Image size 1932x1910 — 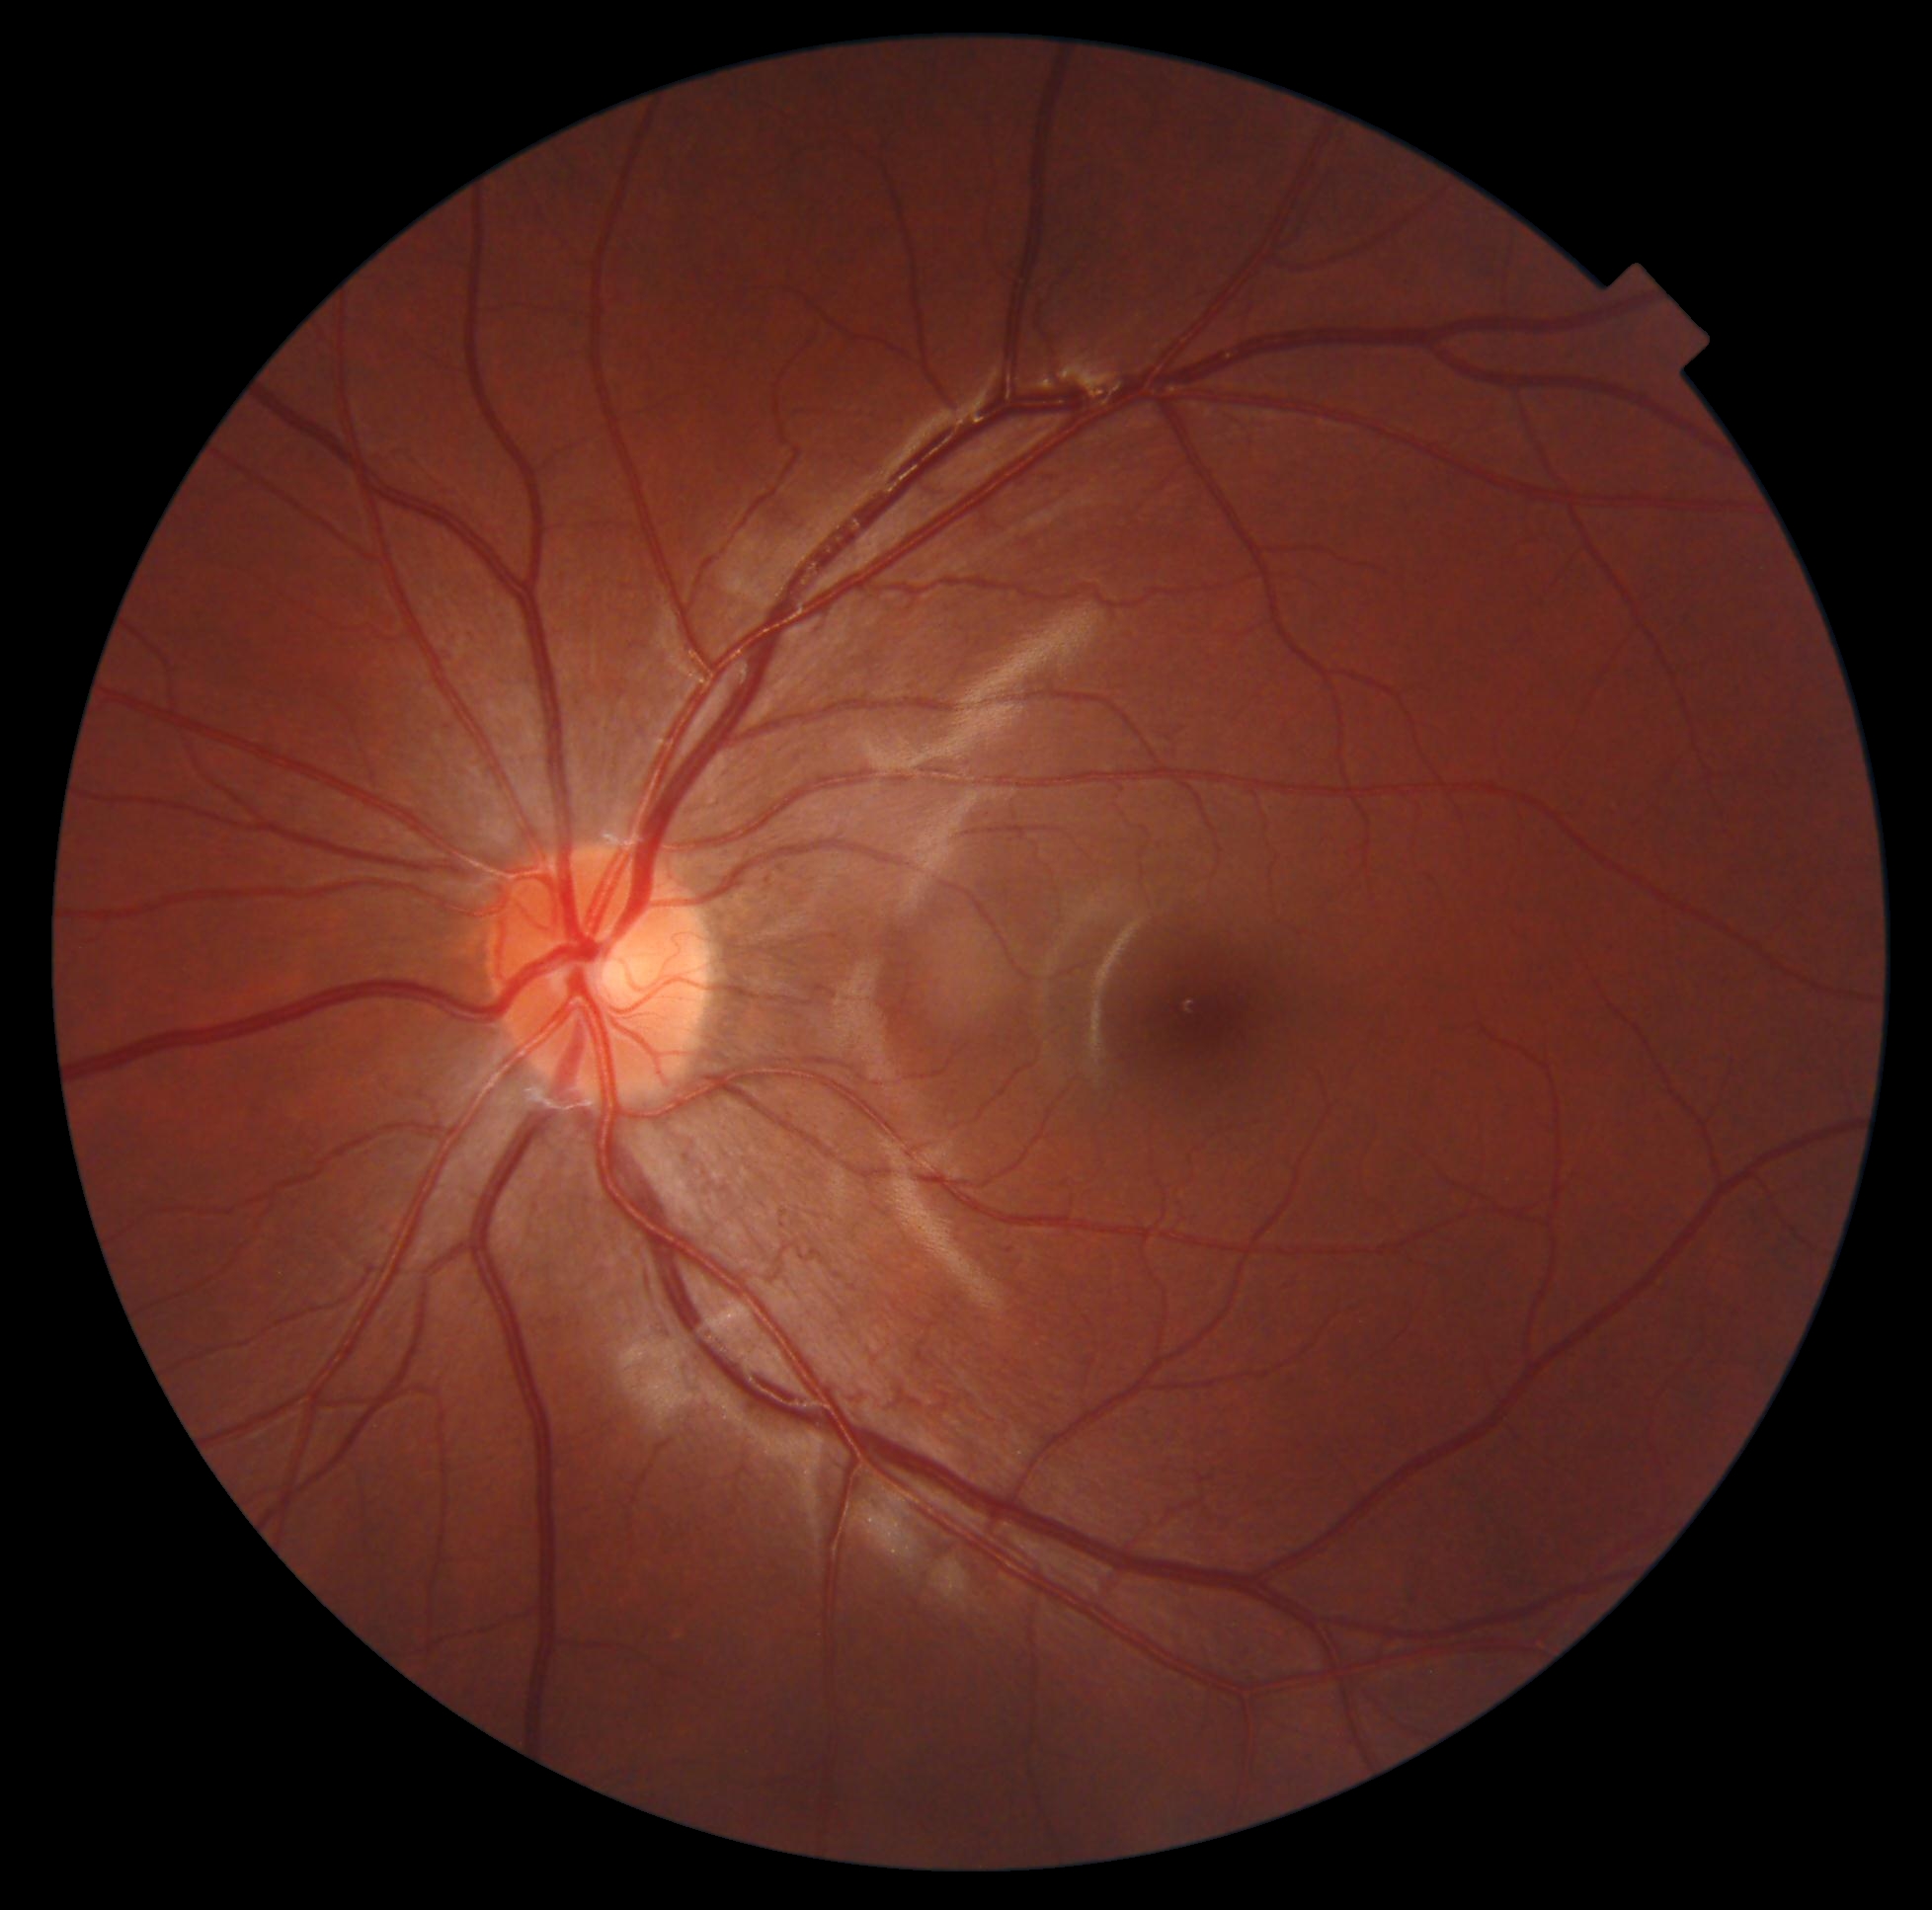
Retinopathy grade is 0.
No diabetic retinal disease findings.